Pediatric wide-field fundus photograph — 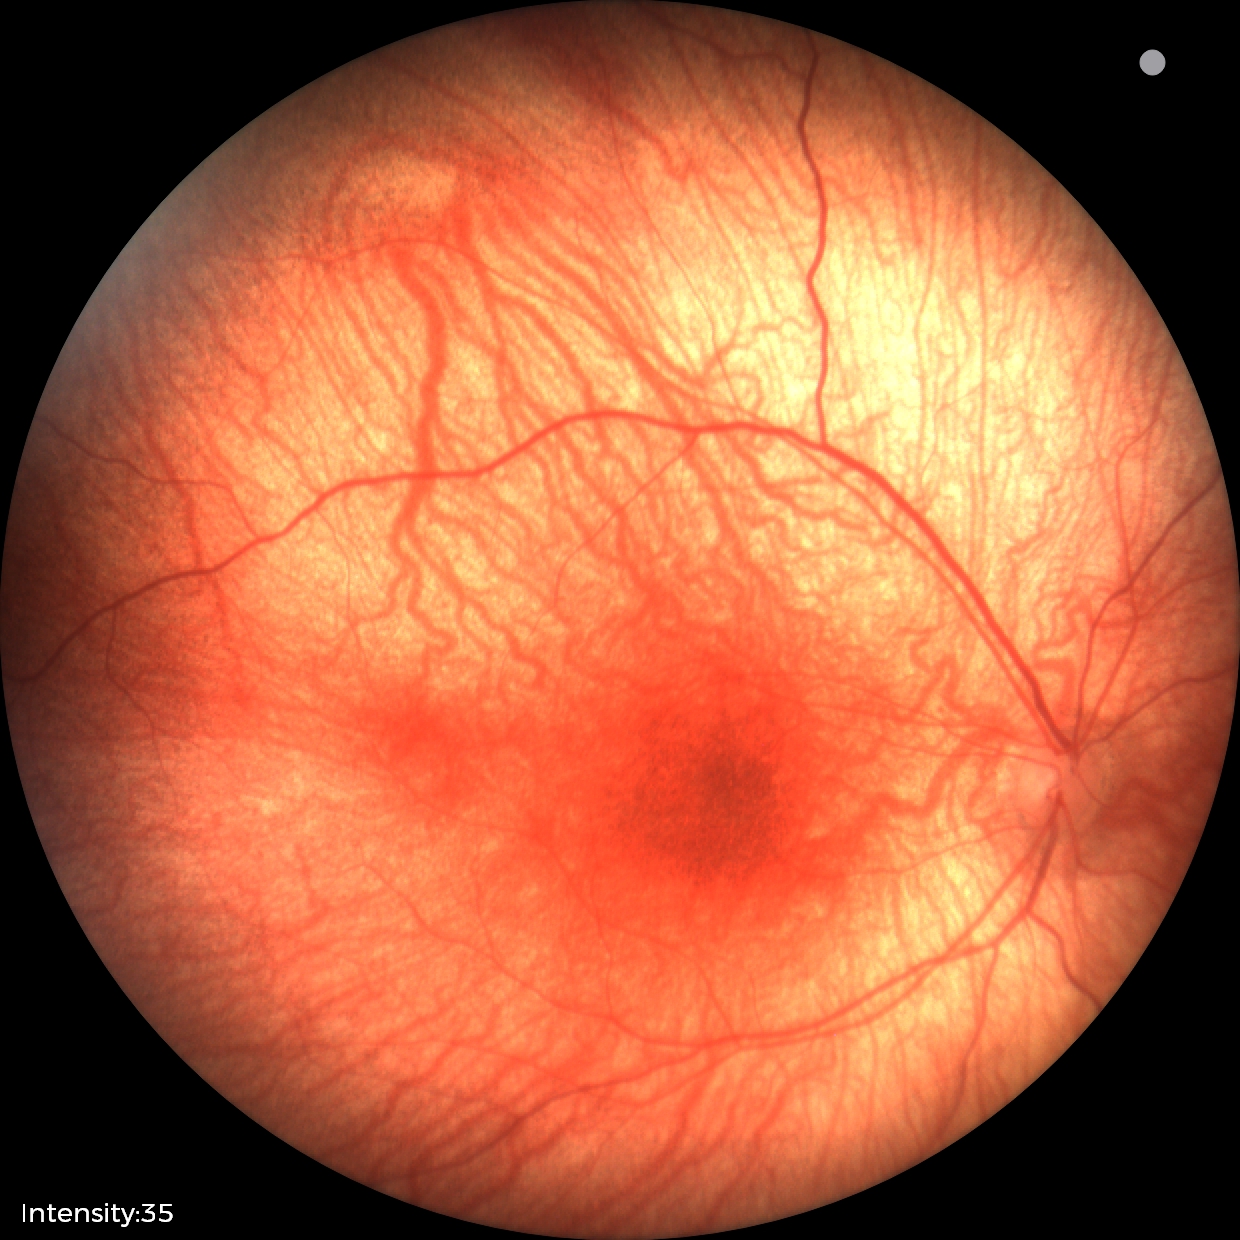

Screening examination diagnosed as physiological.